Captured on a Kowa VX-10α fundus camera
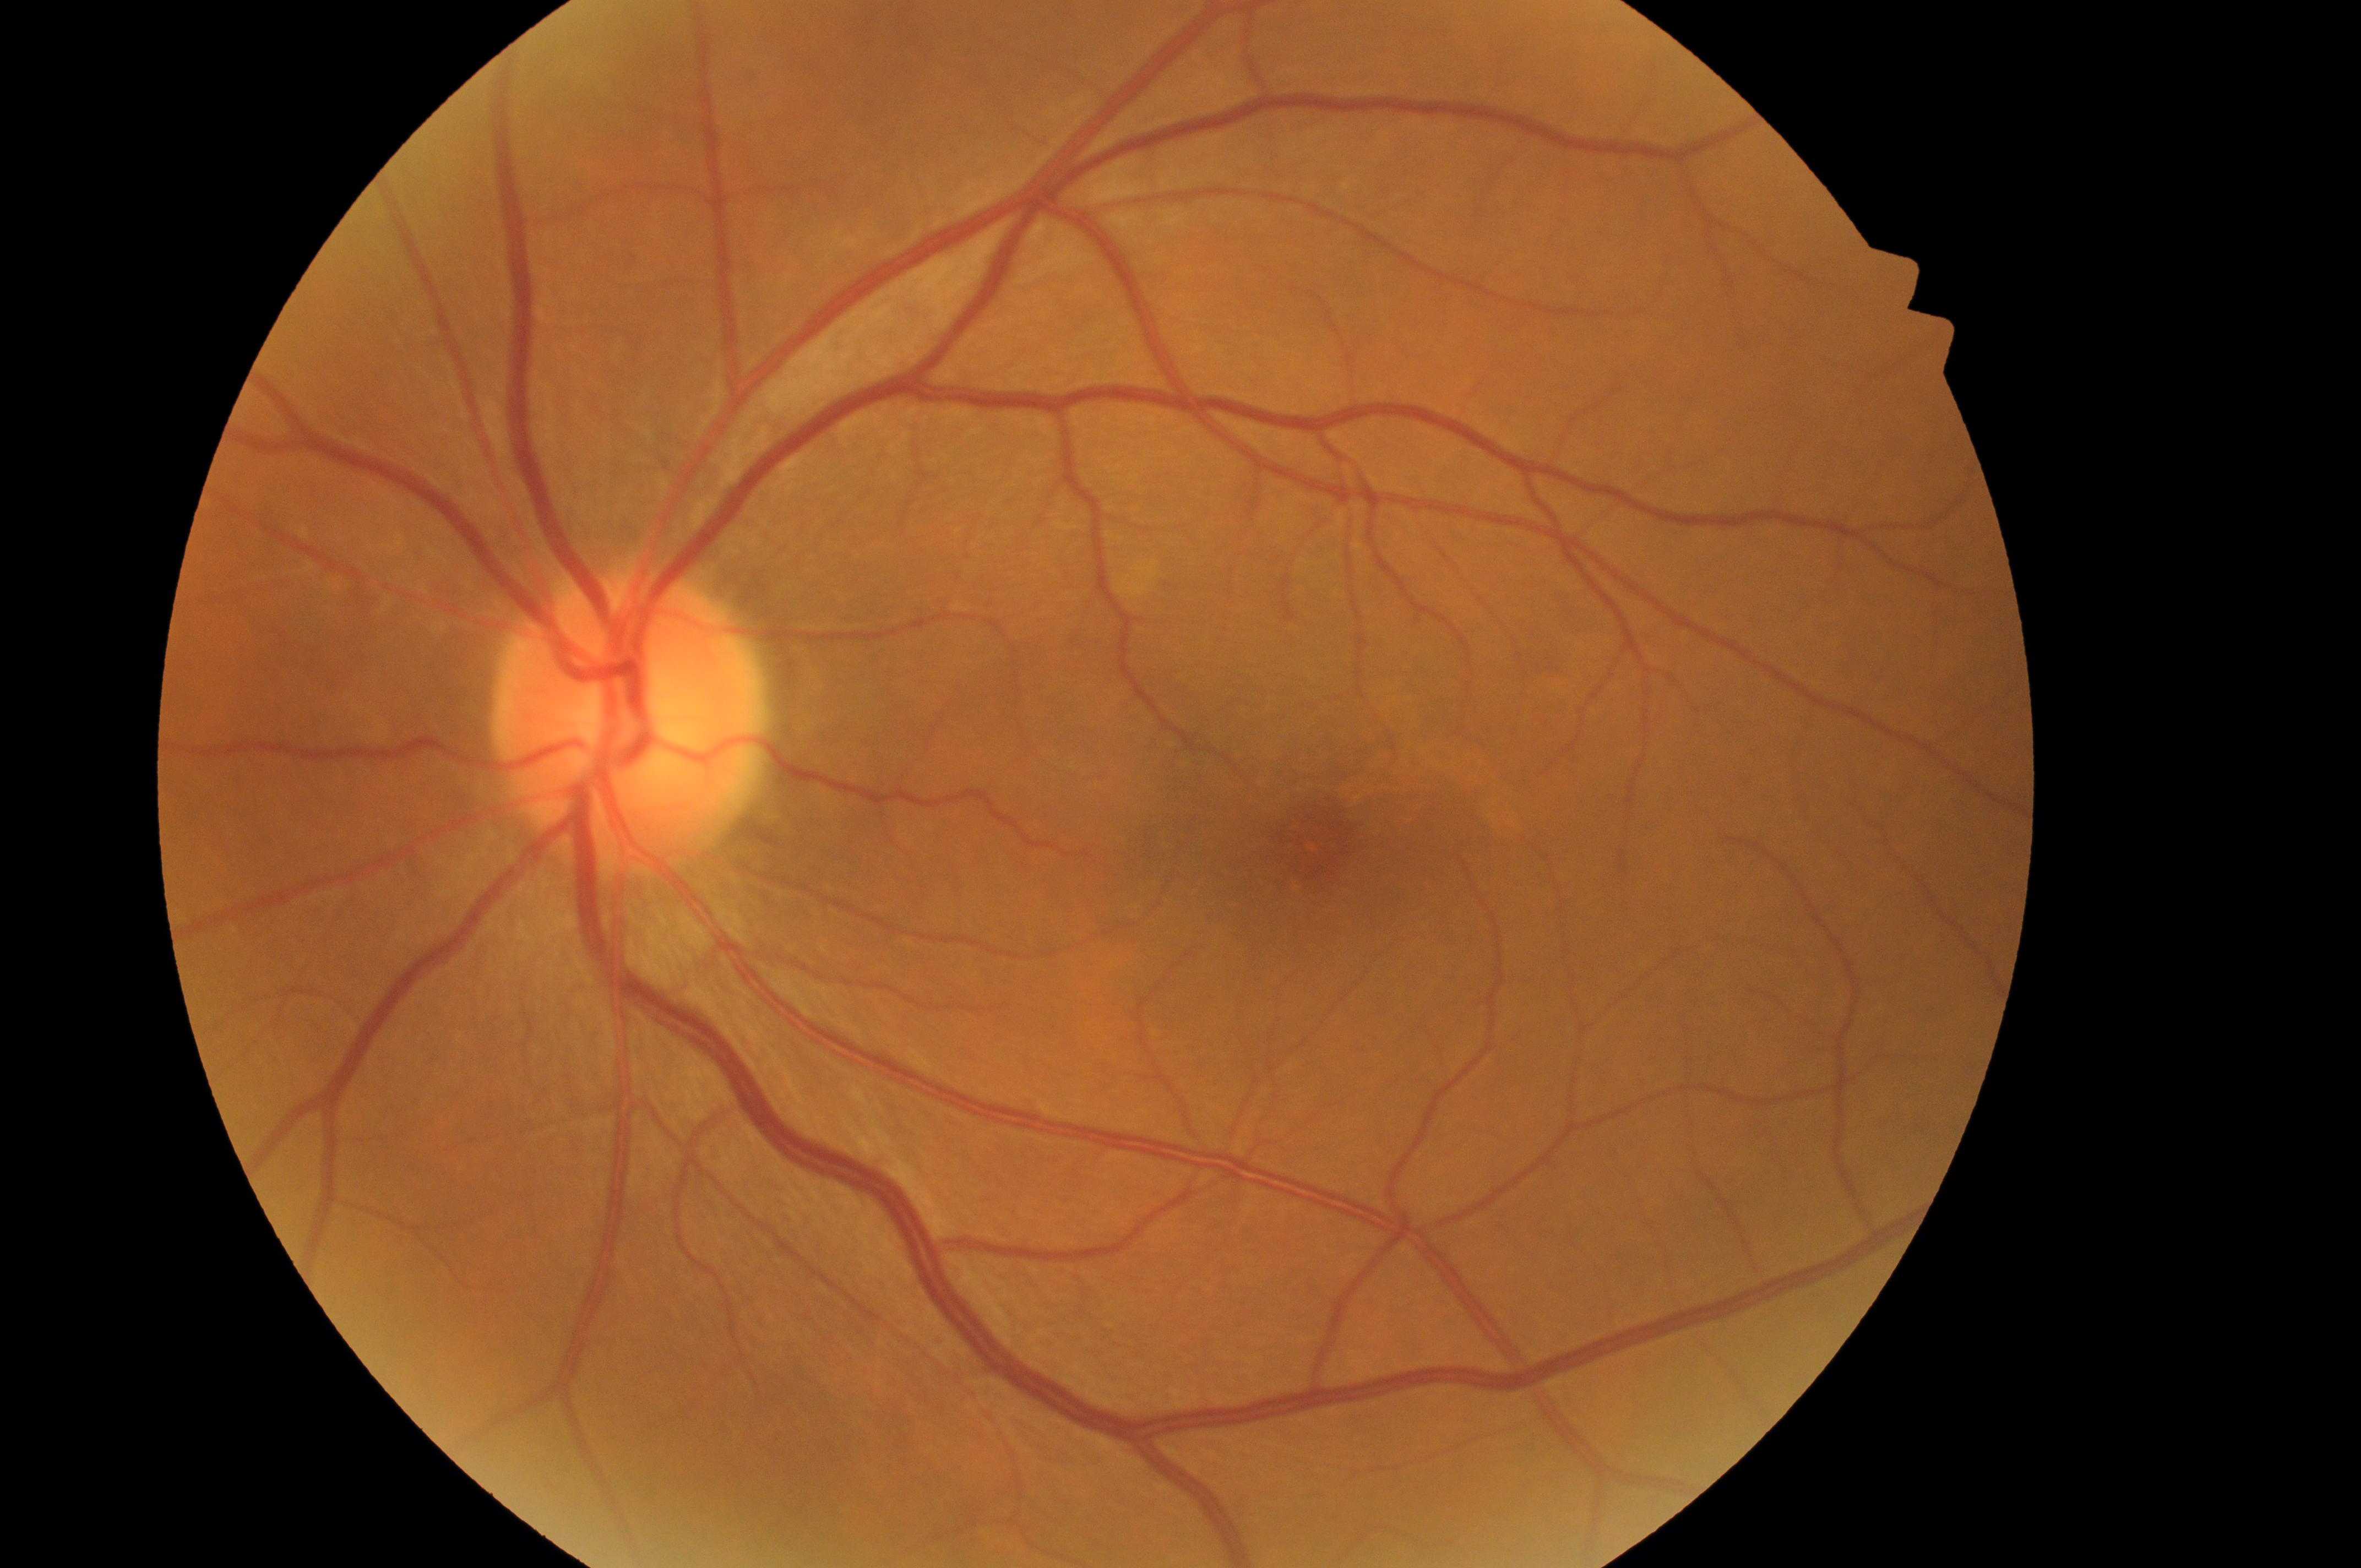
ONH: (x: 629, y: 726).
Fovea center: (x: 1314, y: 847).
Diabetic retinopathy severity: grade 0 (no apparent retinopathy) — no visible signs of diabetic retinopathy.
Diabetic macular edema is grade 0 (no risk) — no apparent hard exudates.
The image shows the left eye.